RetCam wide-field infant fundus image · 1440 by 1080 pixels: 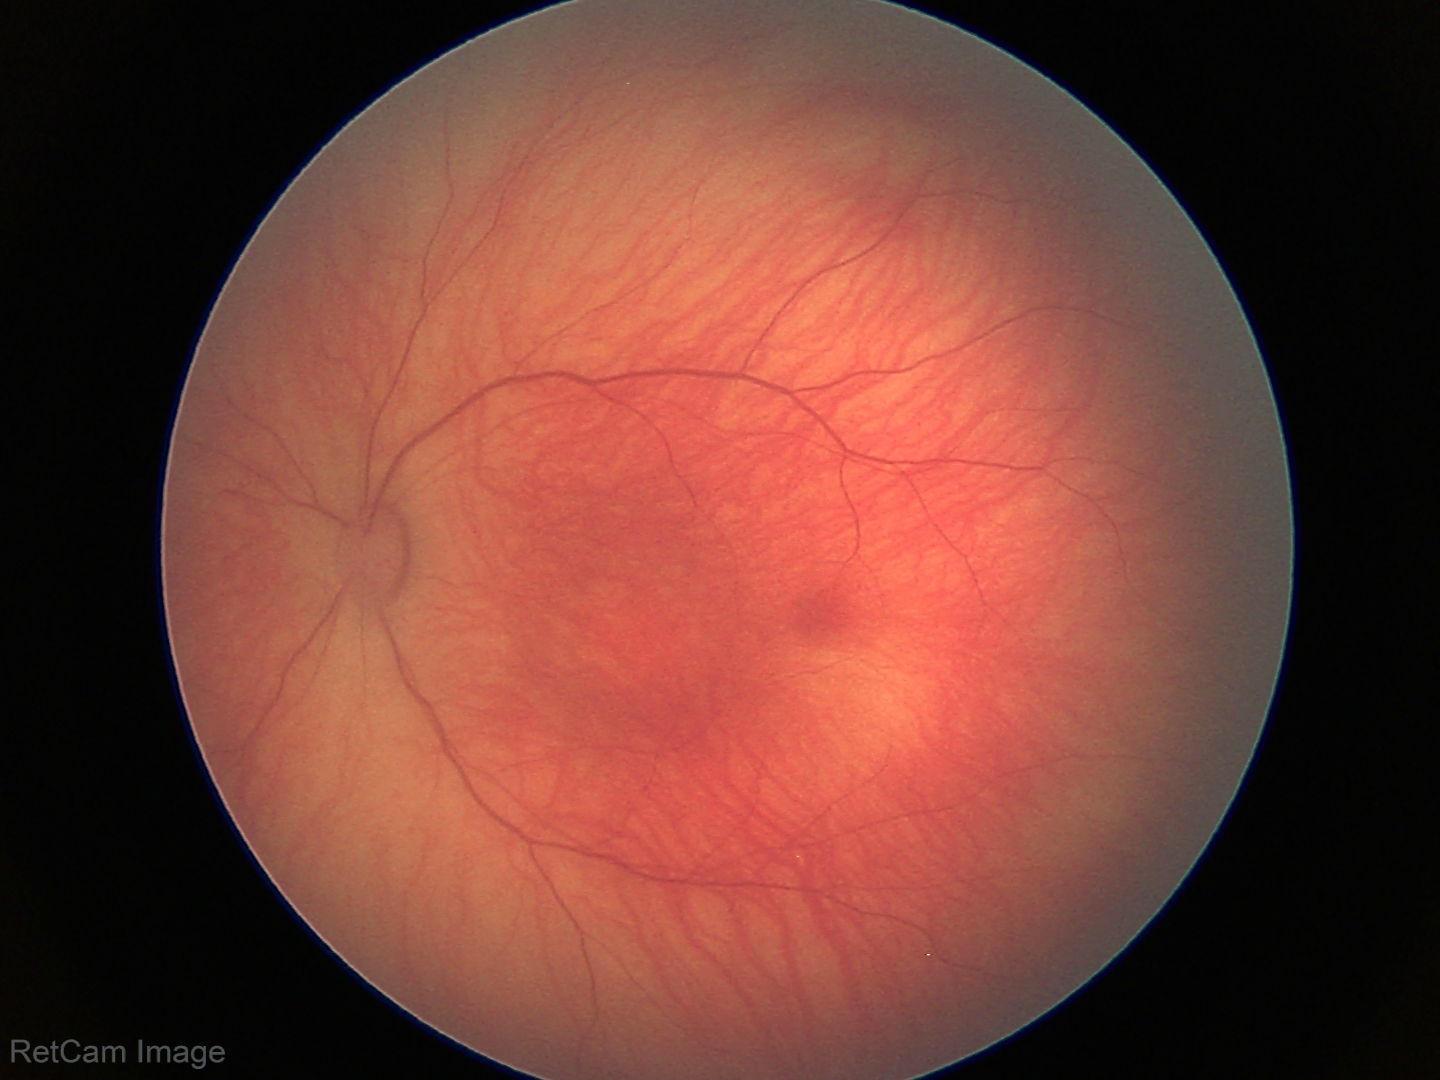 Assessment: physiological appearance